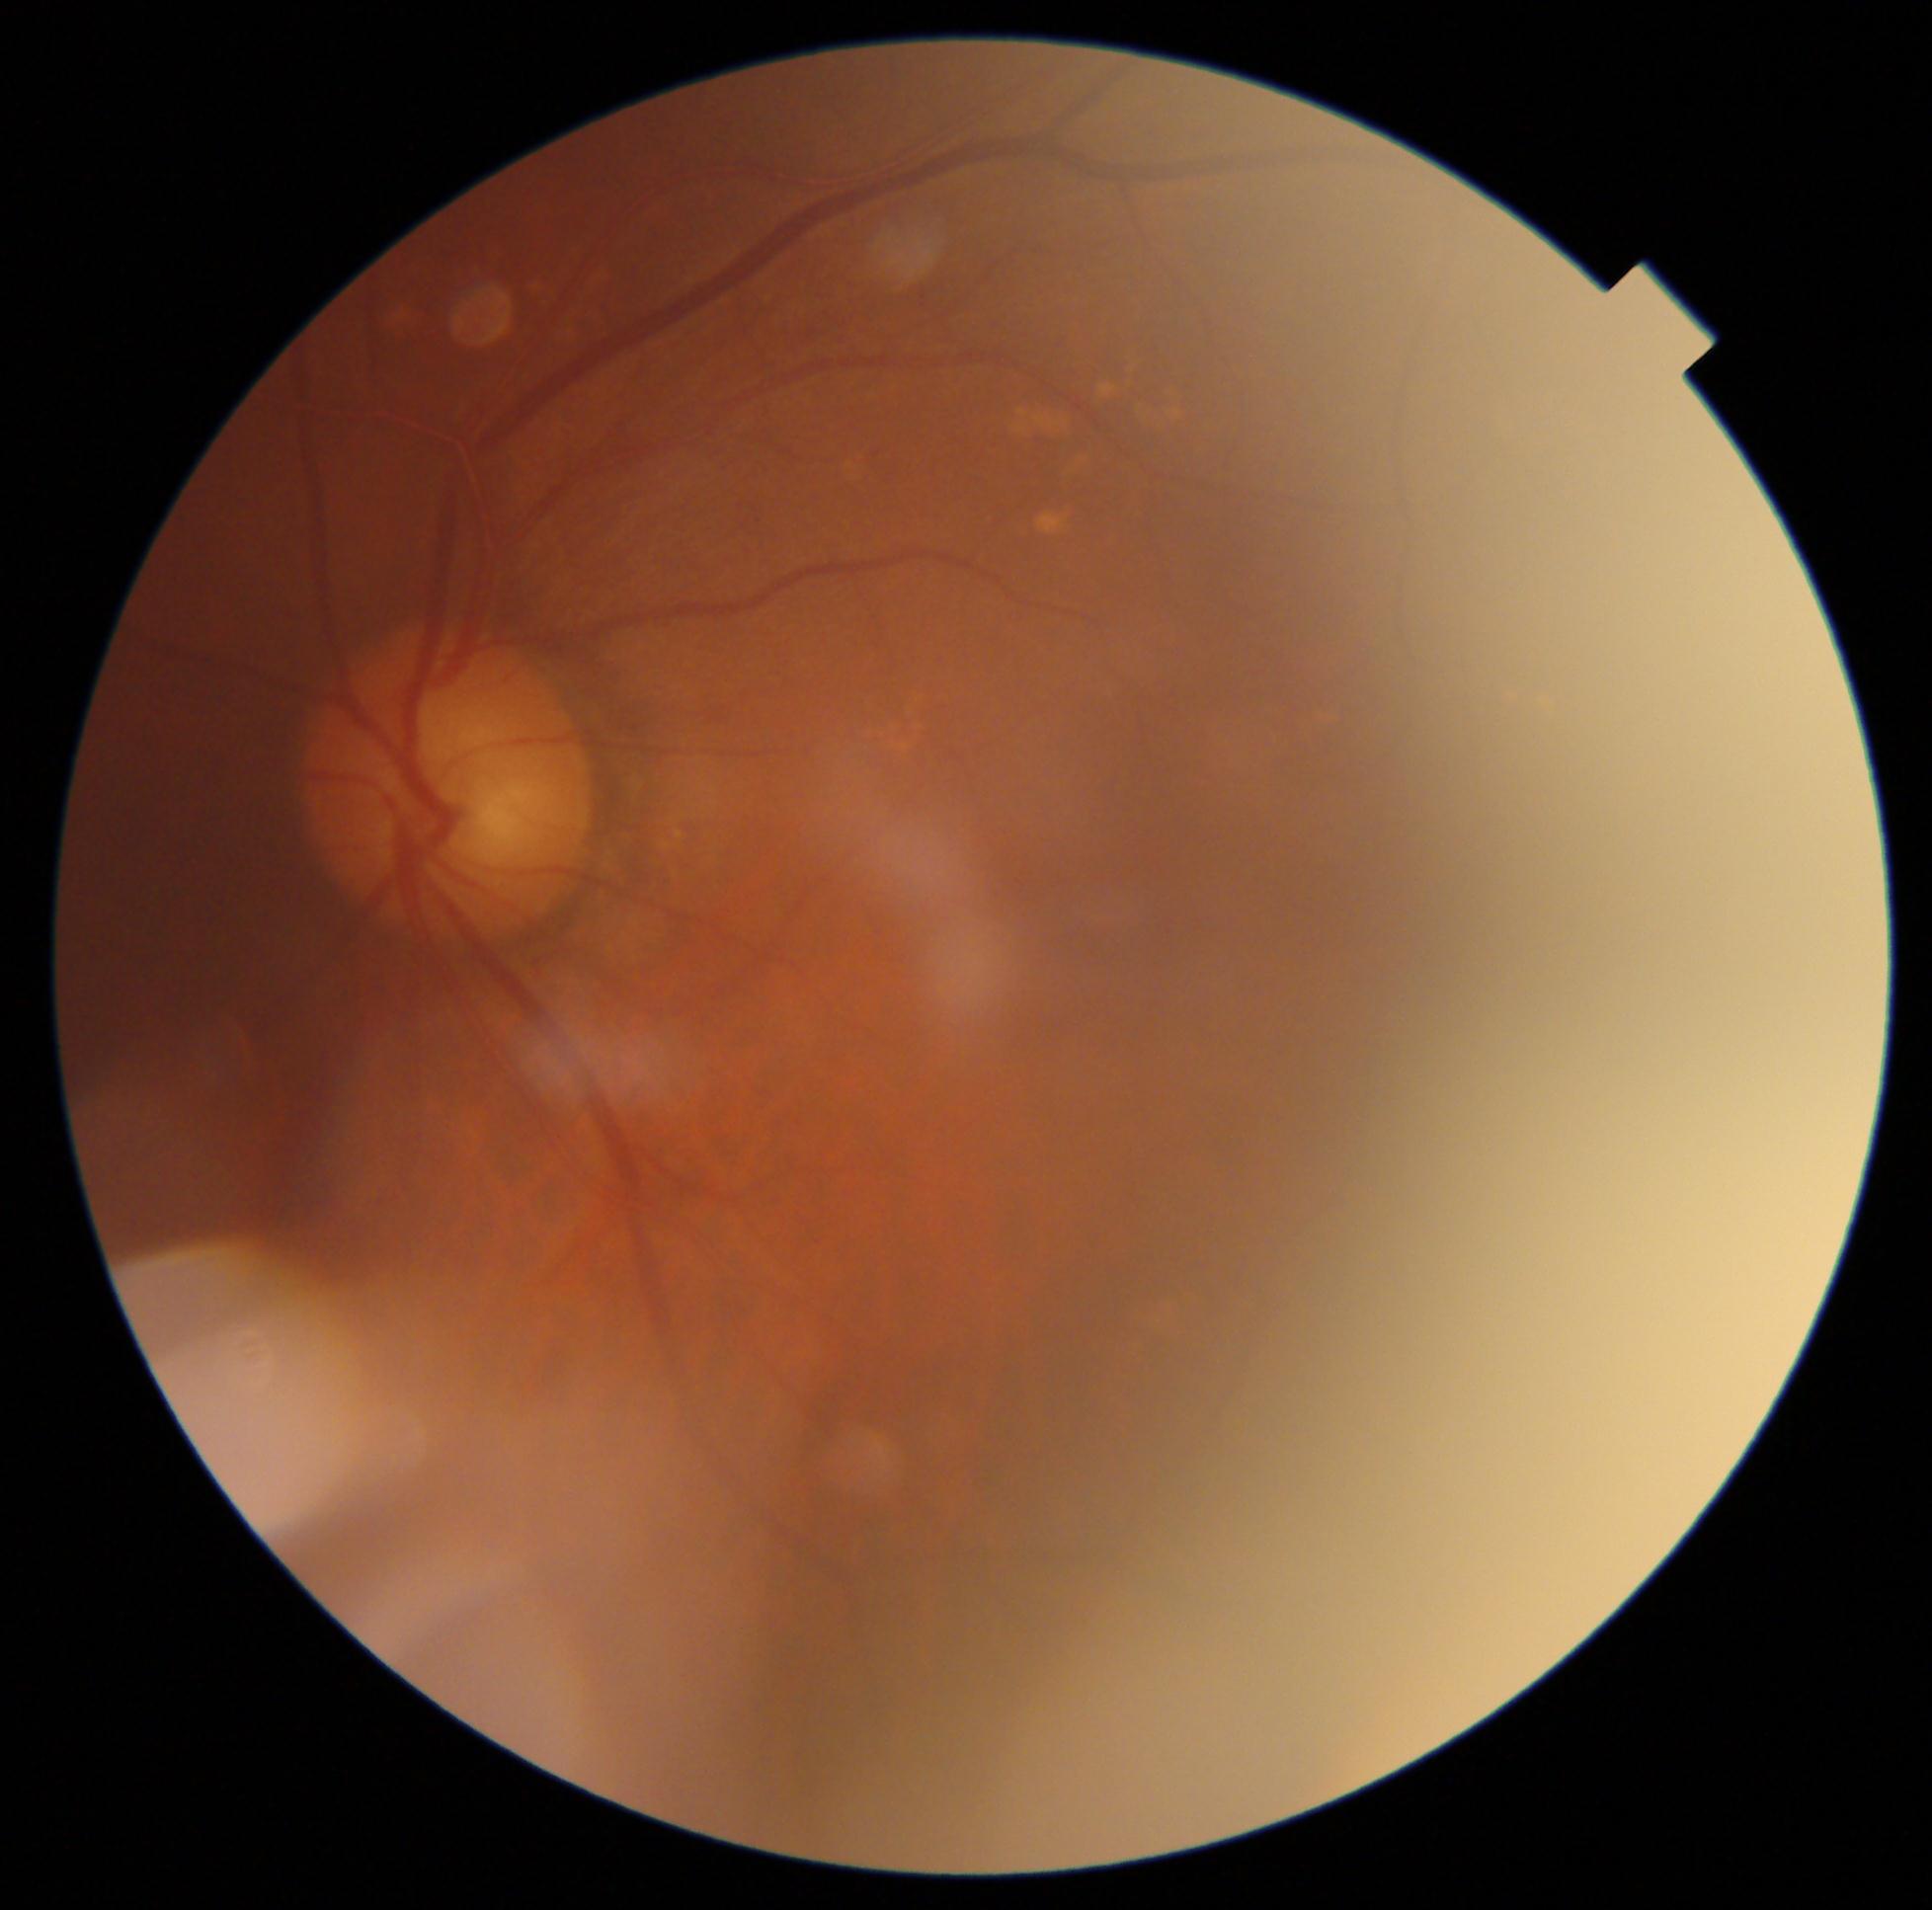
DR grade: 0, DR impression: no apparent DR.